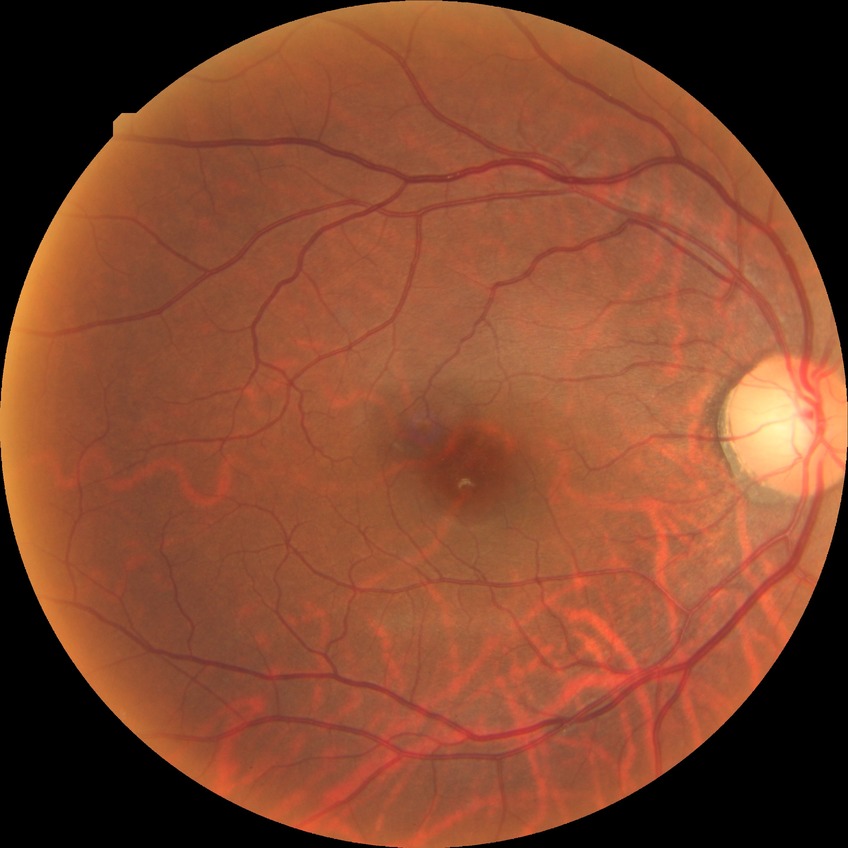 Retinopathy grade: no diabetic retinopathy.